Image size 1920x1440
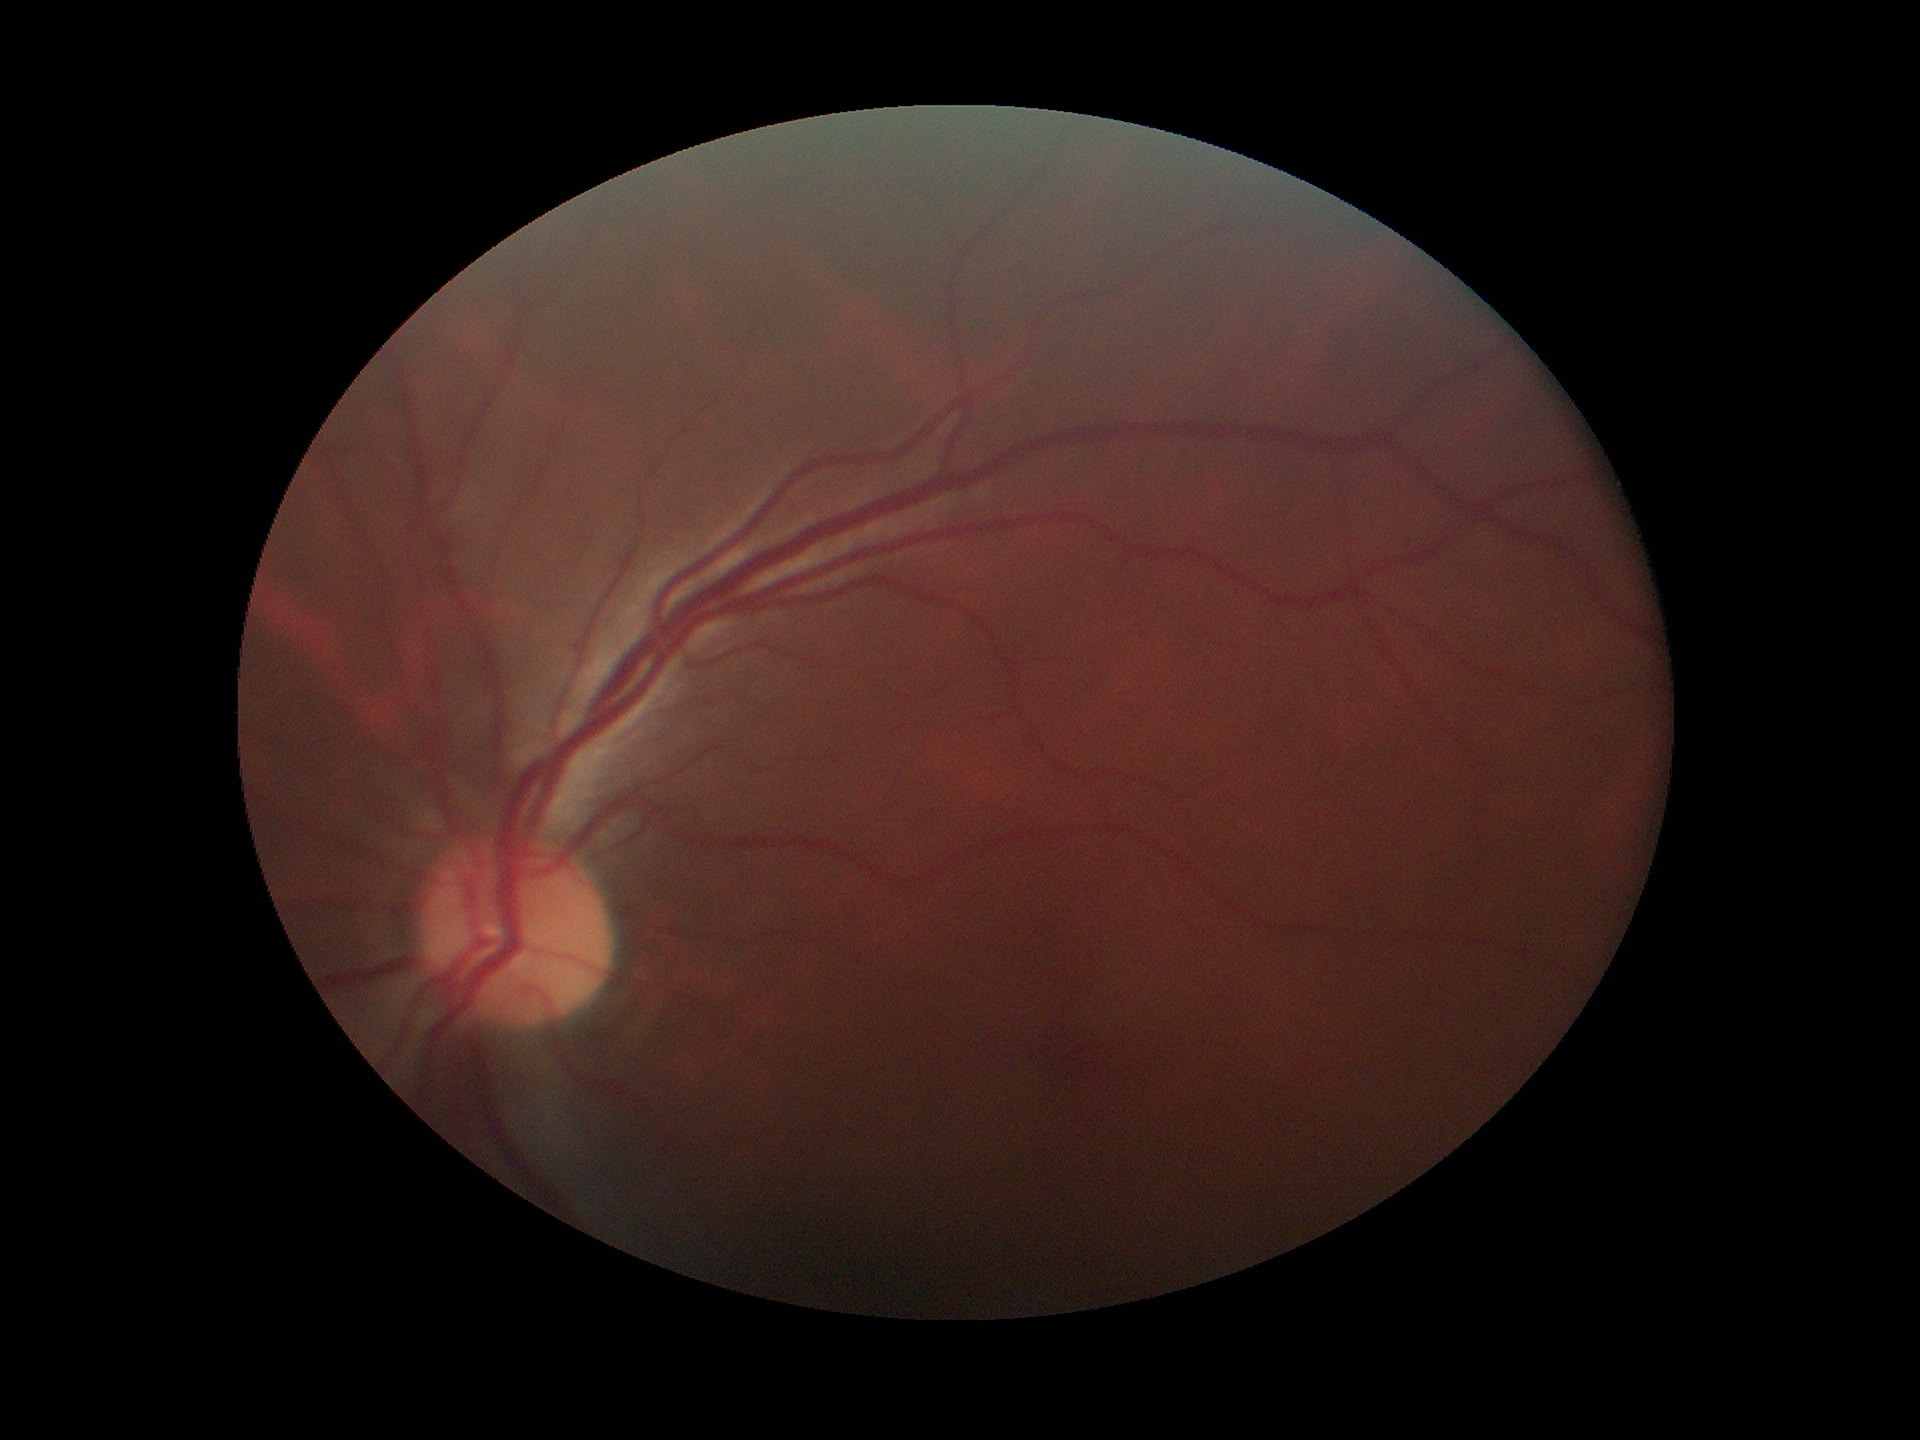

Glaucoma screening impression: no suspicious findings
vertical cup-to-disc ratio: 0.46
horizontal C/D ratio: 0.42